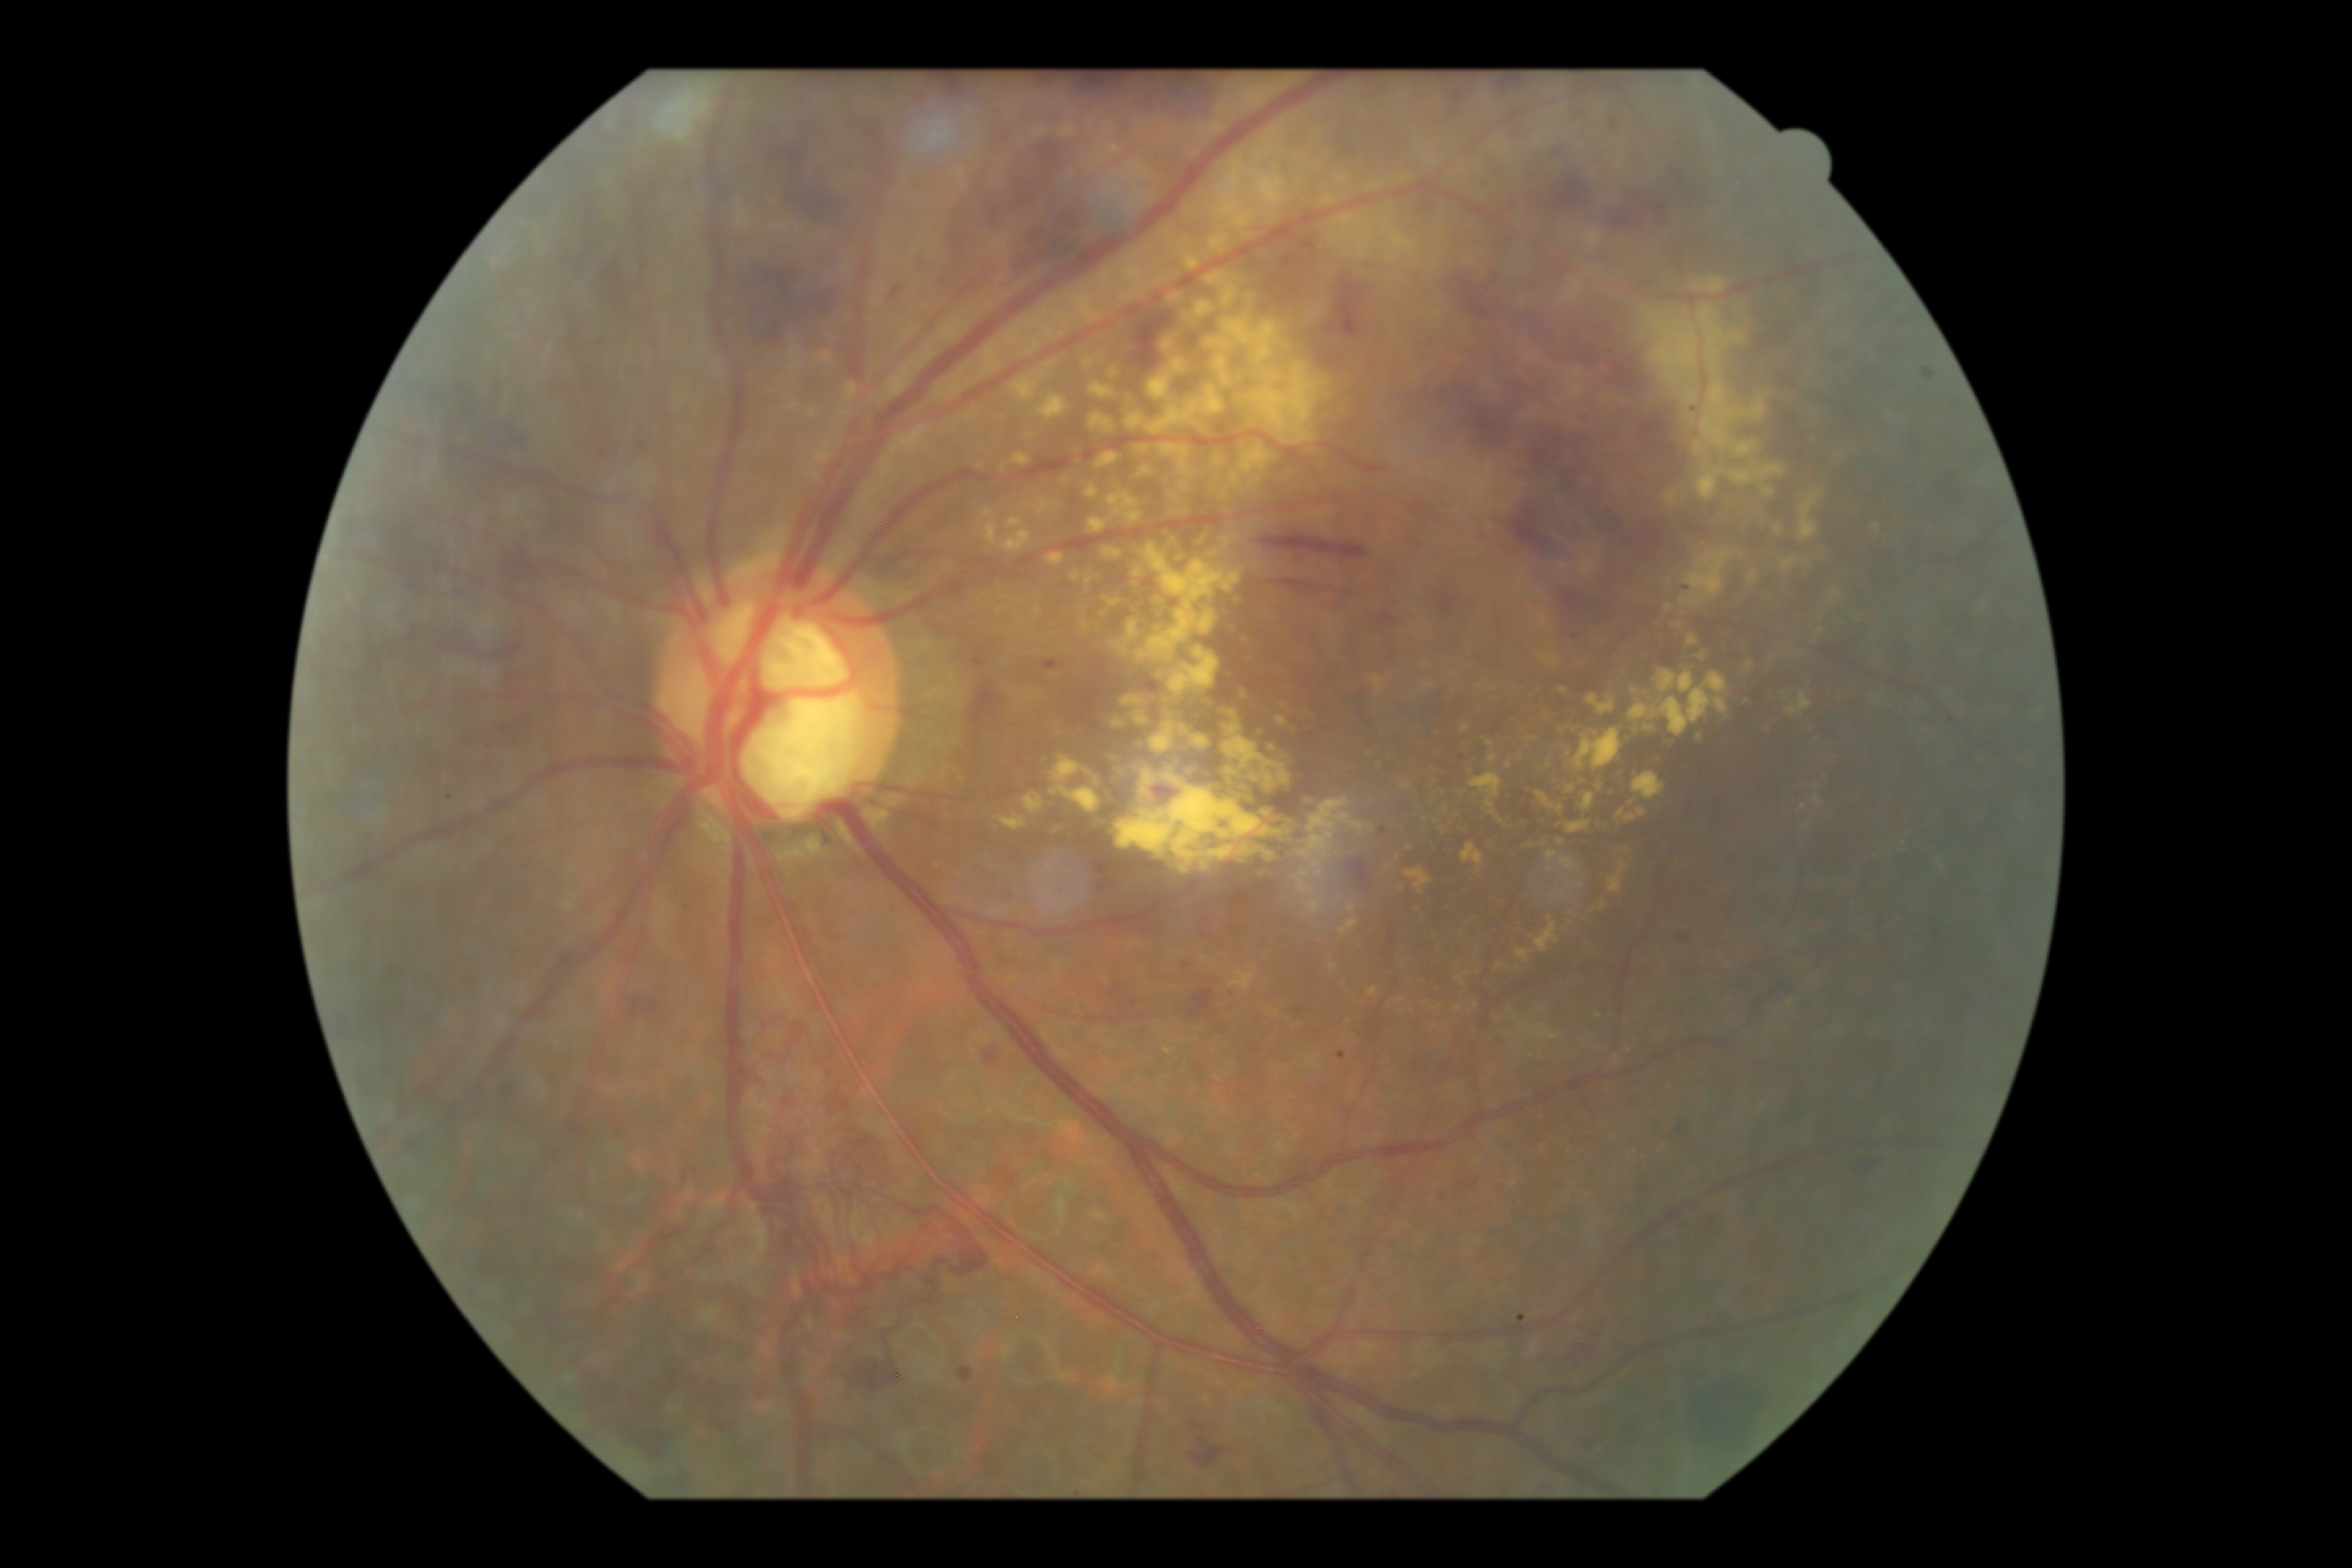
Diabetic retinopathy is 4/4. Disease class: proliferative diabetic retinopathy.